Image size 848x848, acquired with a NIDEK AFC-230, nonmydriatic fundus photograph.
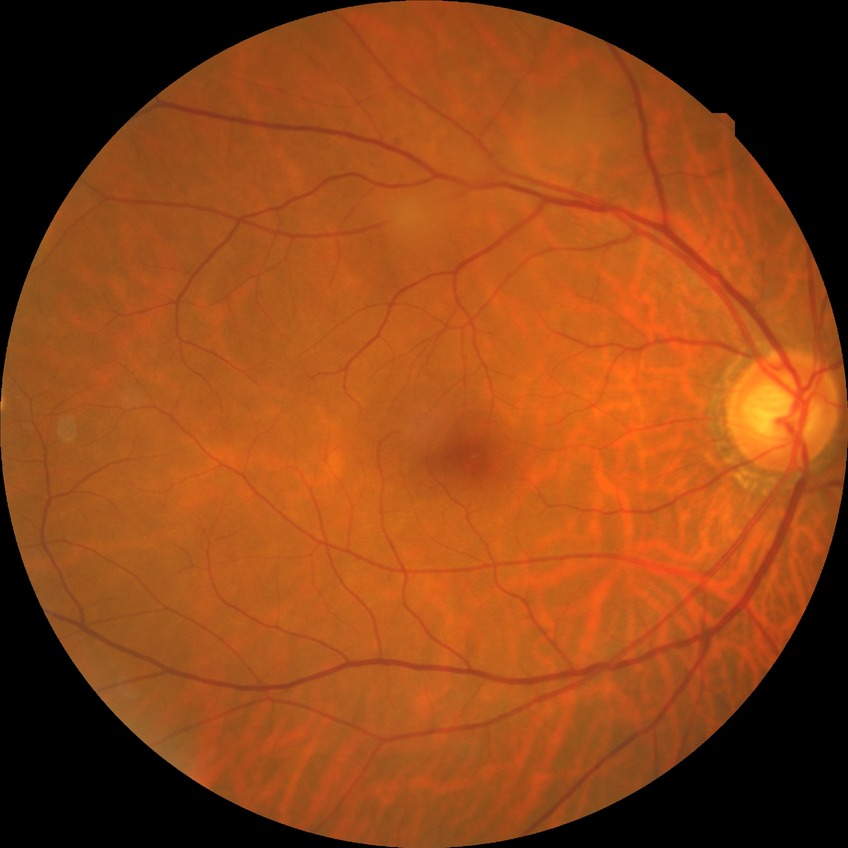
diabetic retinopathy (DR) = no diabetic retinopathy (NDR)